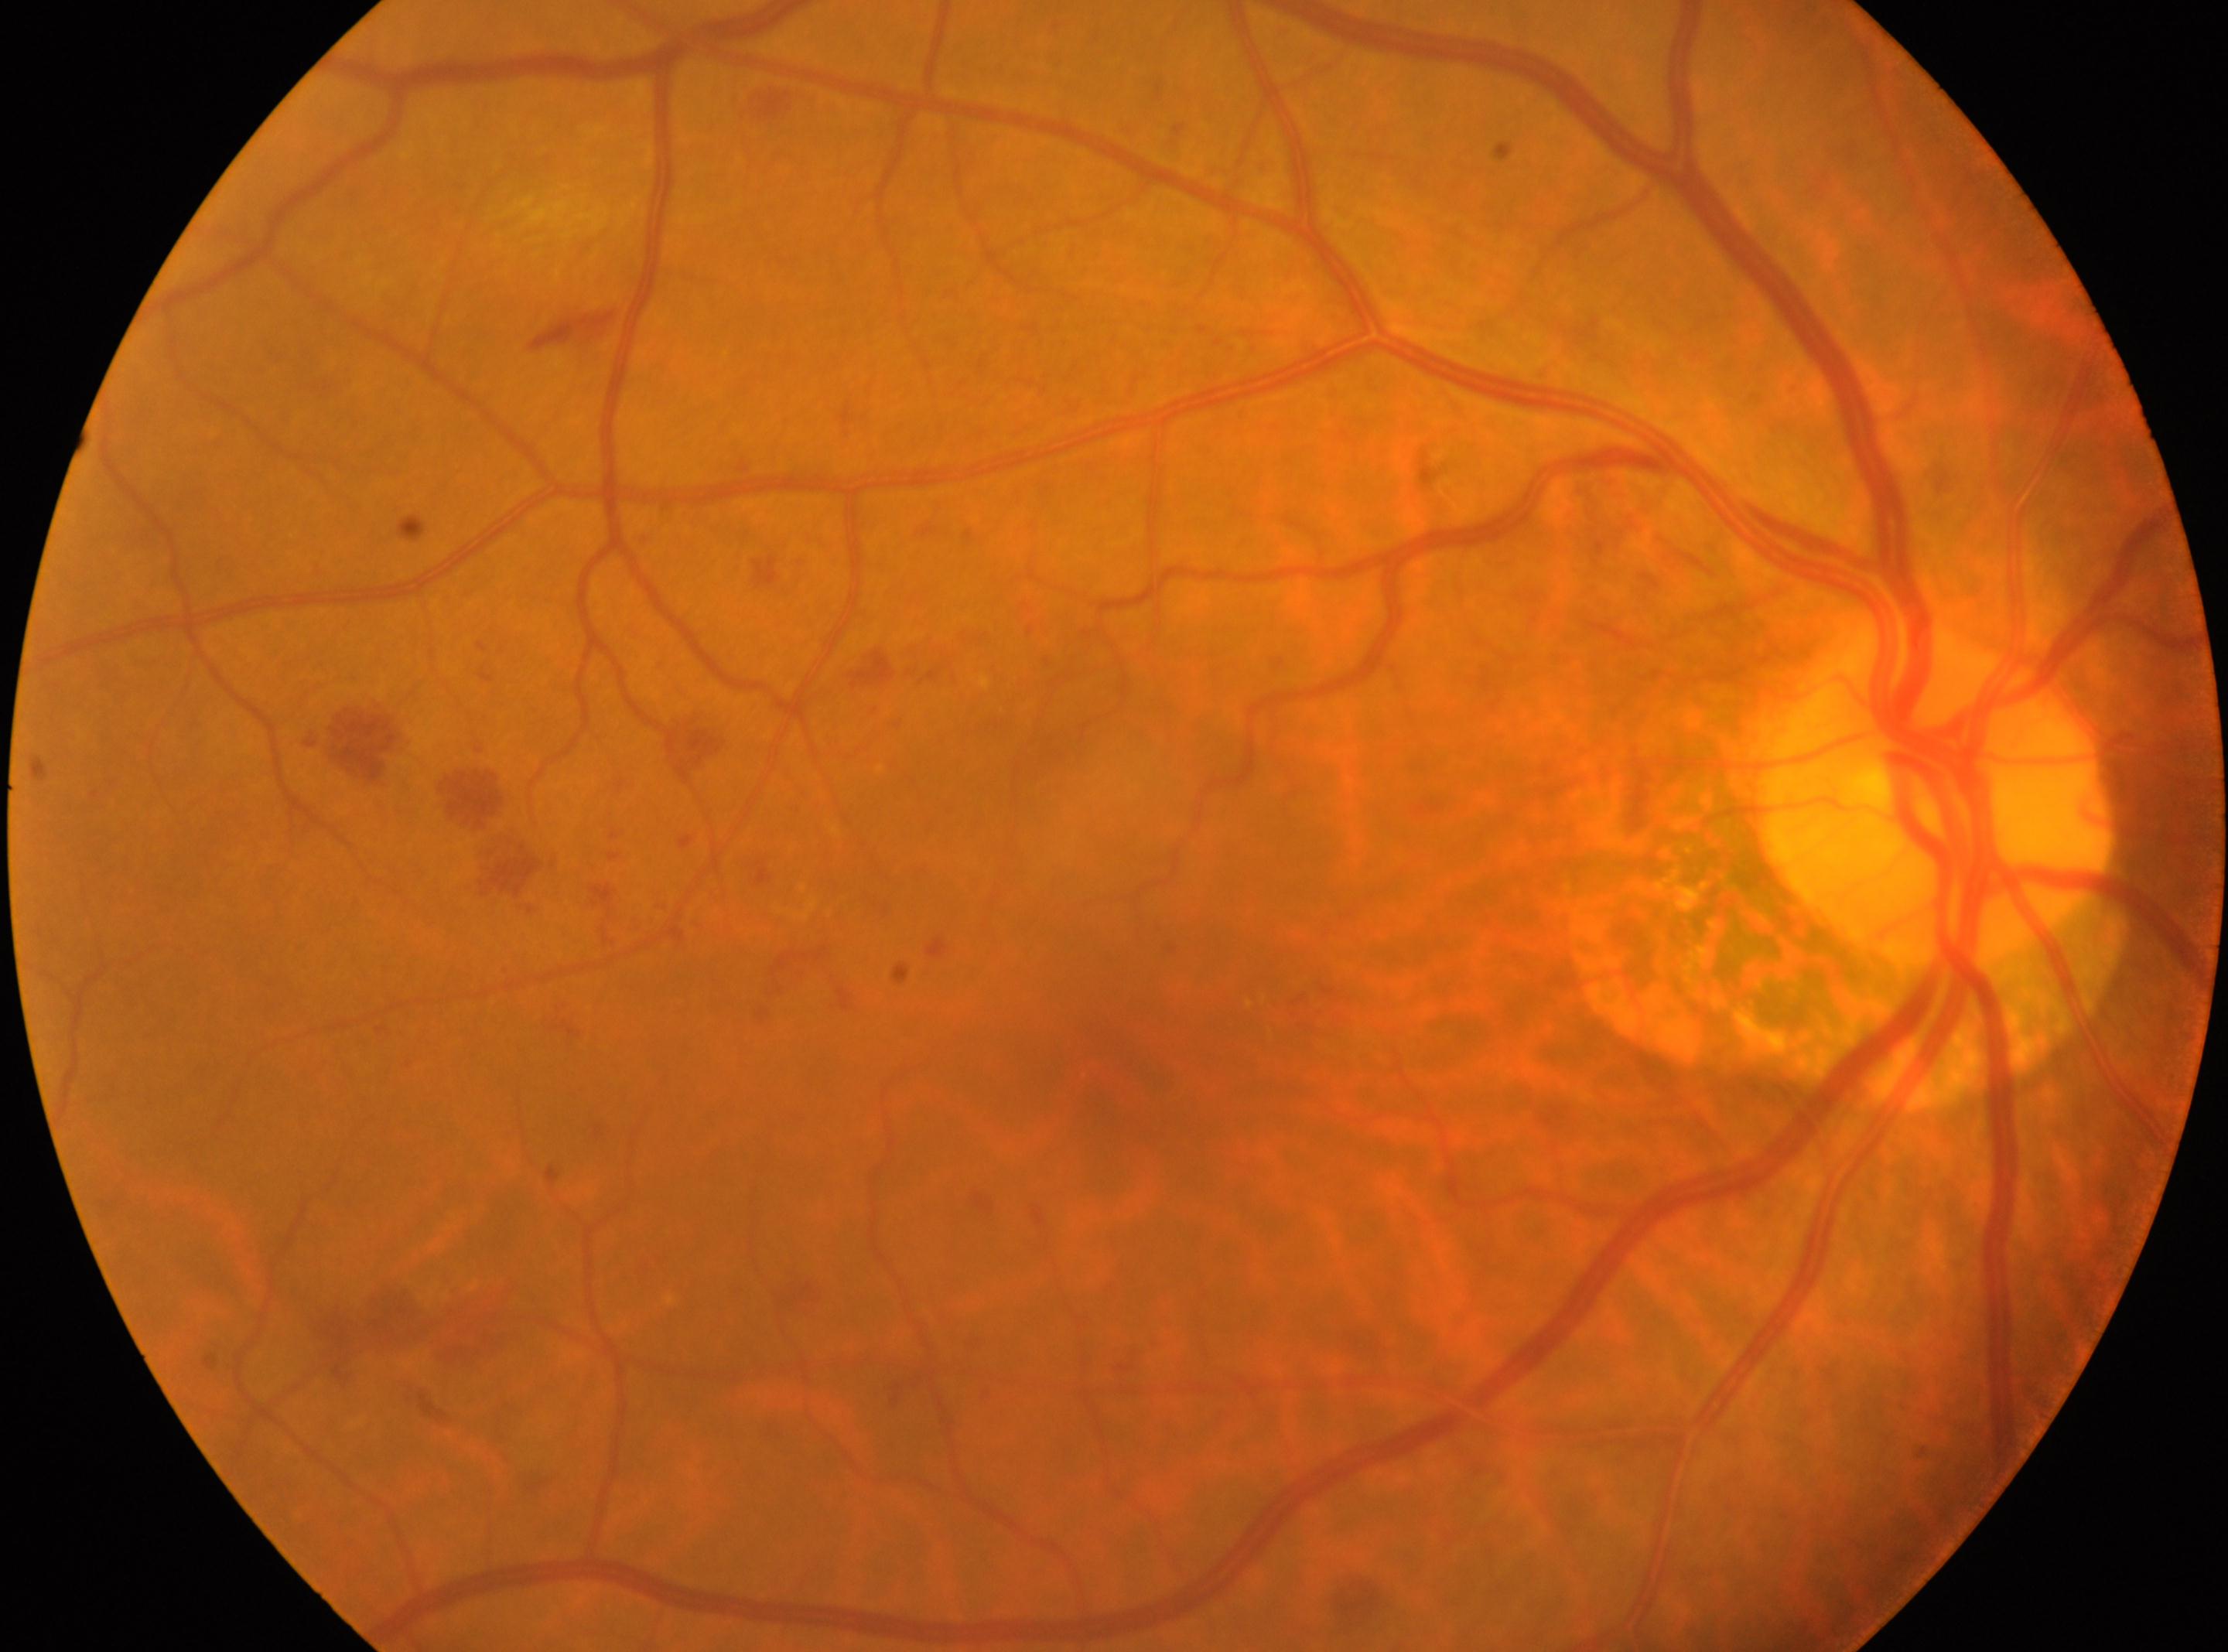
The retinopathy is classified as non-proliferative diabetic retinopathy. The image shows the oculus dexter. The macular center is at (1133, 1060). Retinopathy grade: mild NPDR (1). The optic disc is at (1932, 796).